512 by 512 pixels:
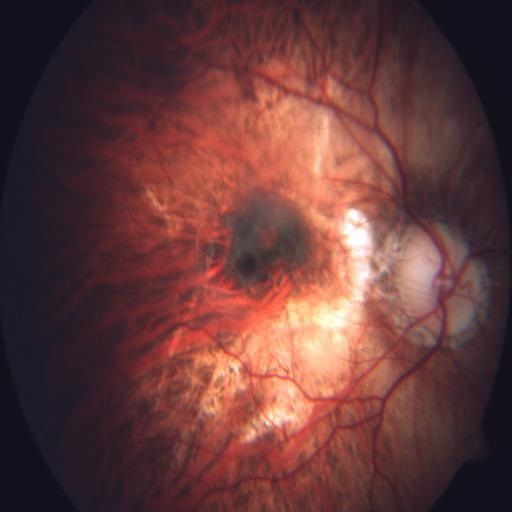
Abnormalities:
- myopia
- neovascularization